2352x1568px · Canon CR-1: 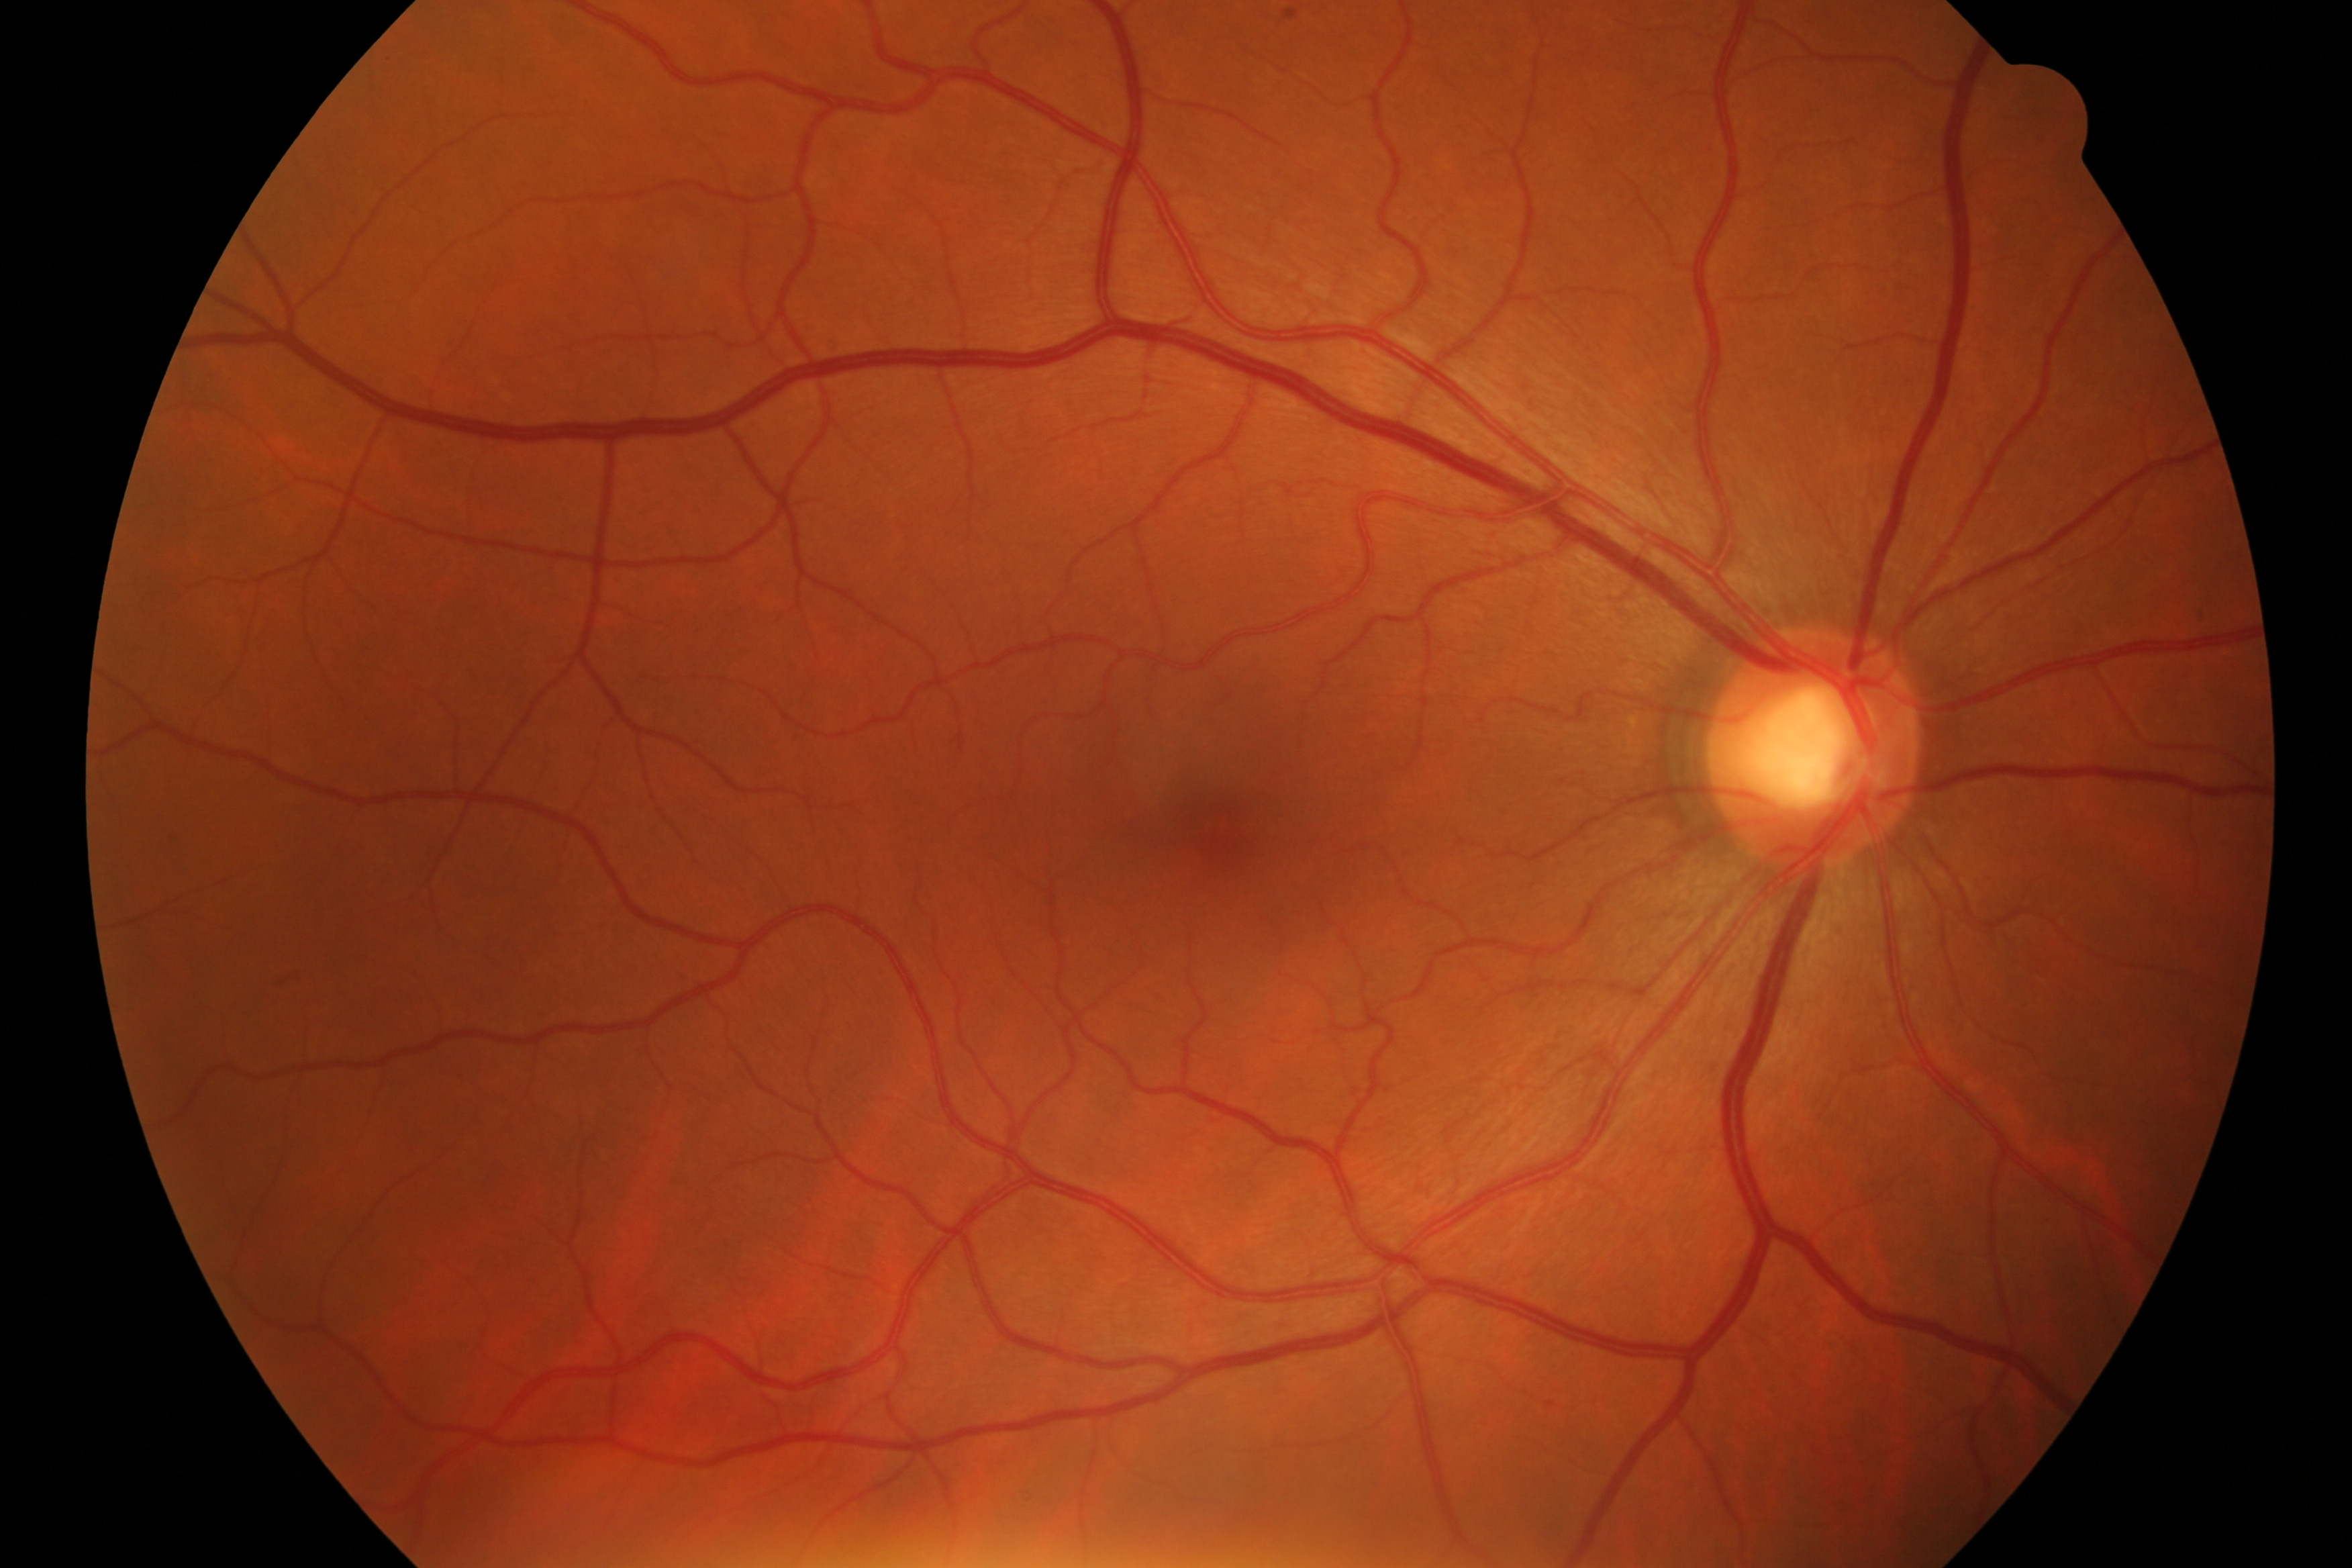 Findings: no DR or glaucomatous changes.